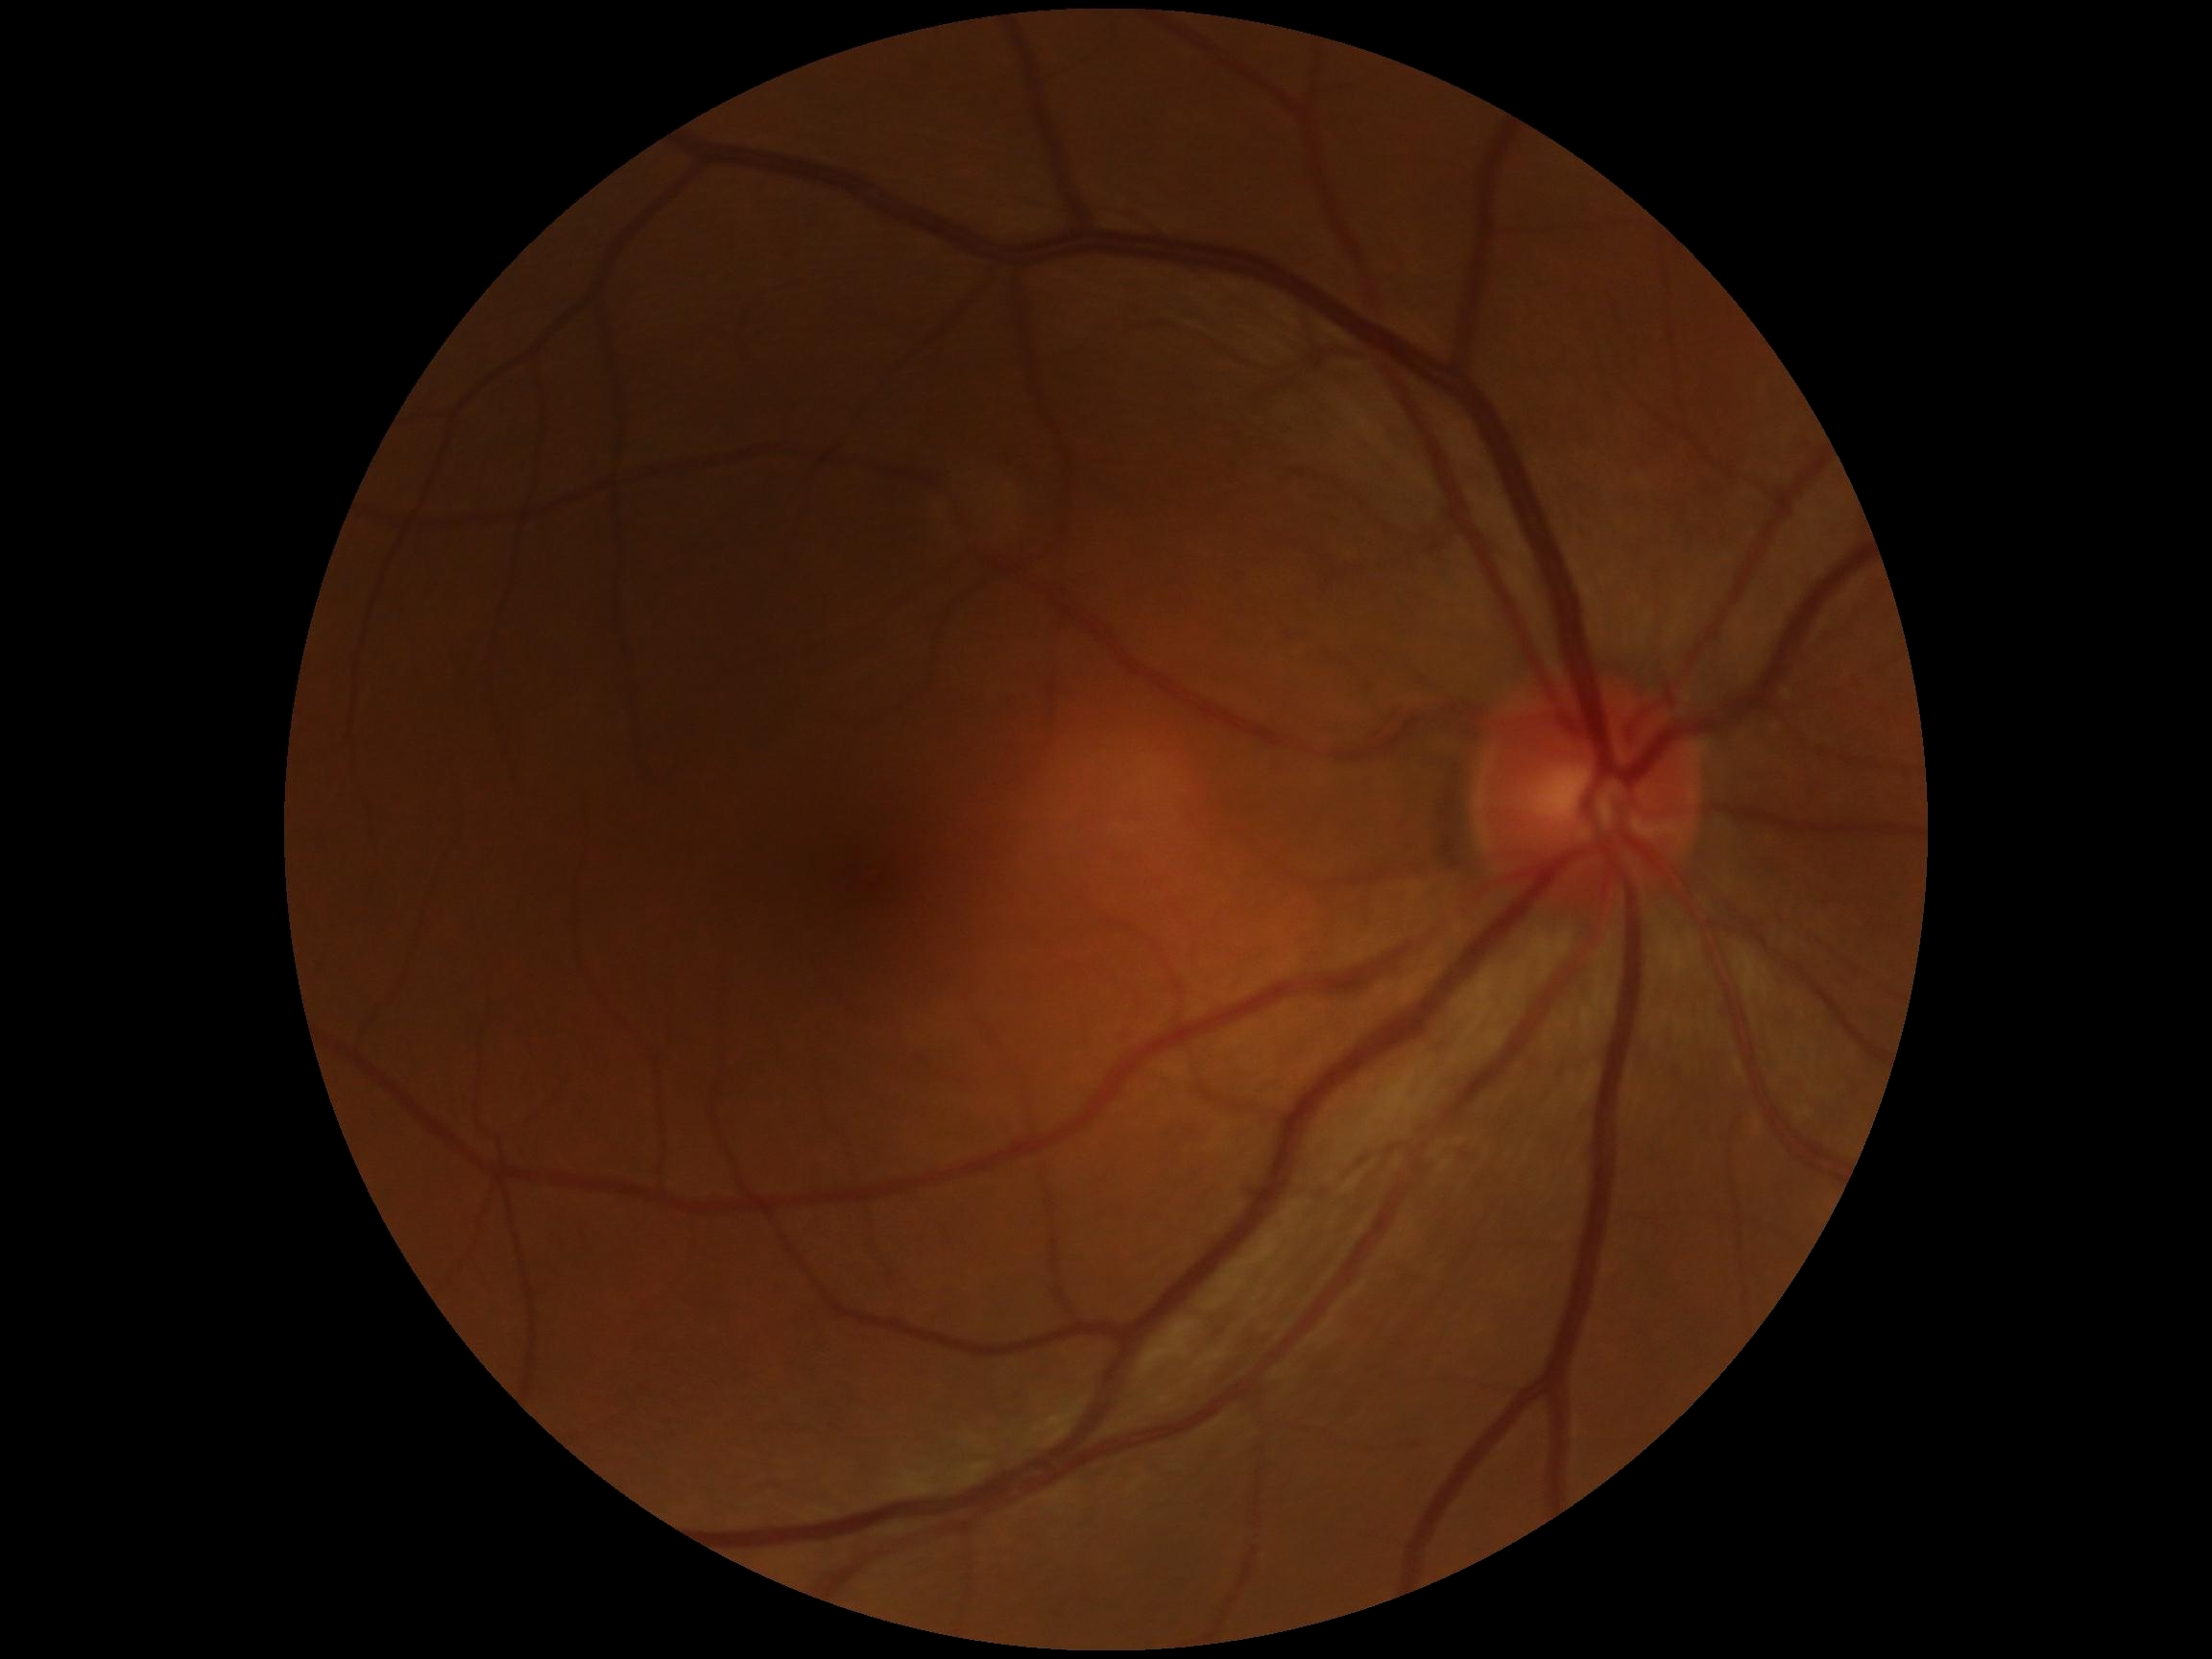 DR=0.